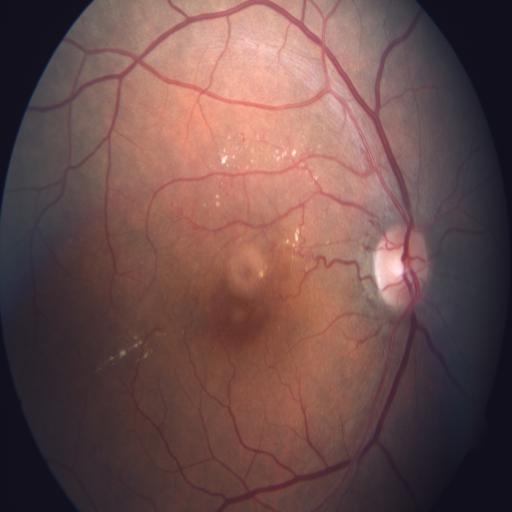
Fundus appearance consistent with CME (cystoid macular edema) and CRS (chorioretinitis).